Color fundus image — 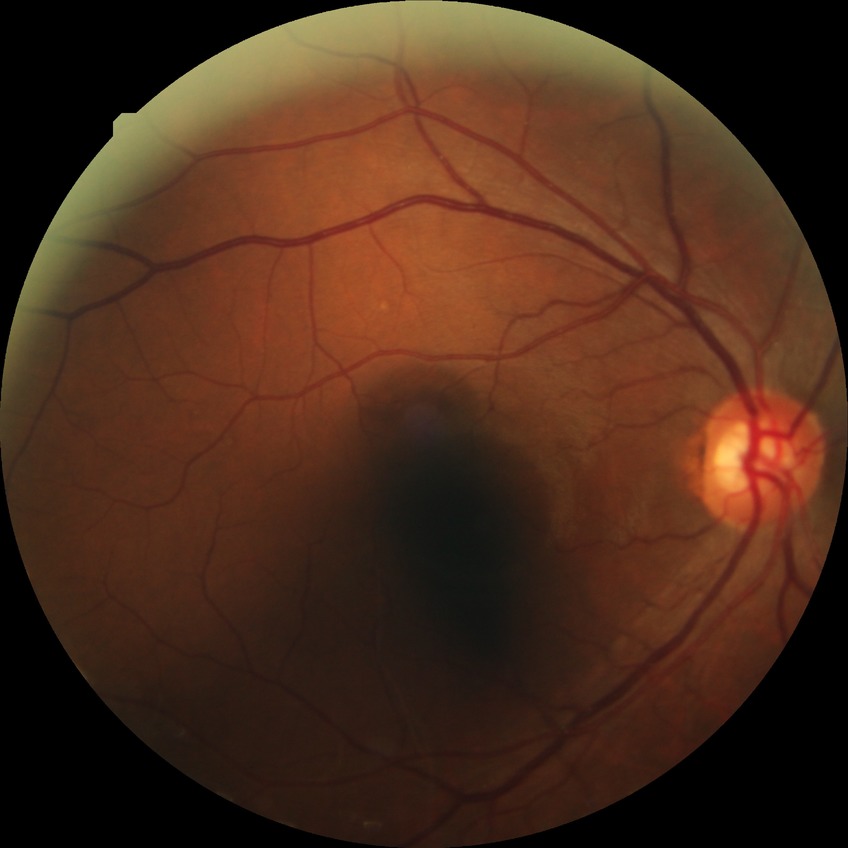 DR severity: NDR.